2352 by 1568 pixels; CFP; FOV: 45 degrees:
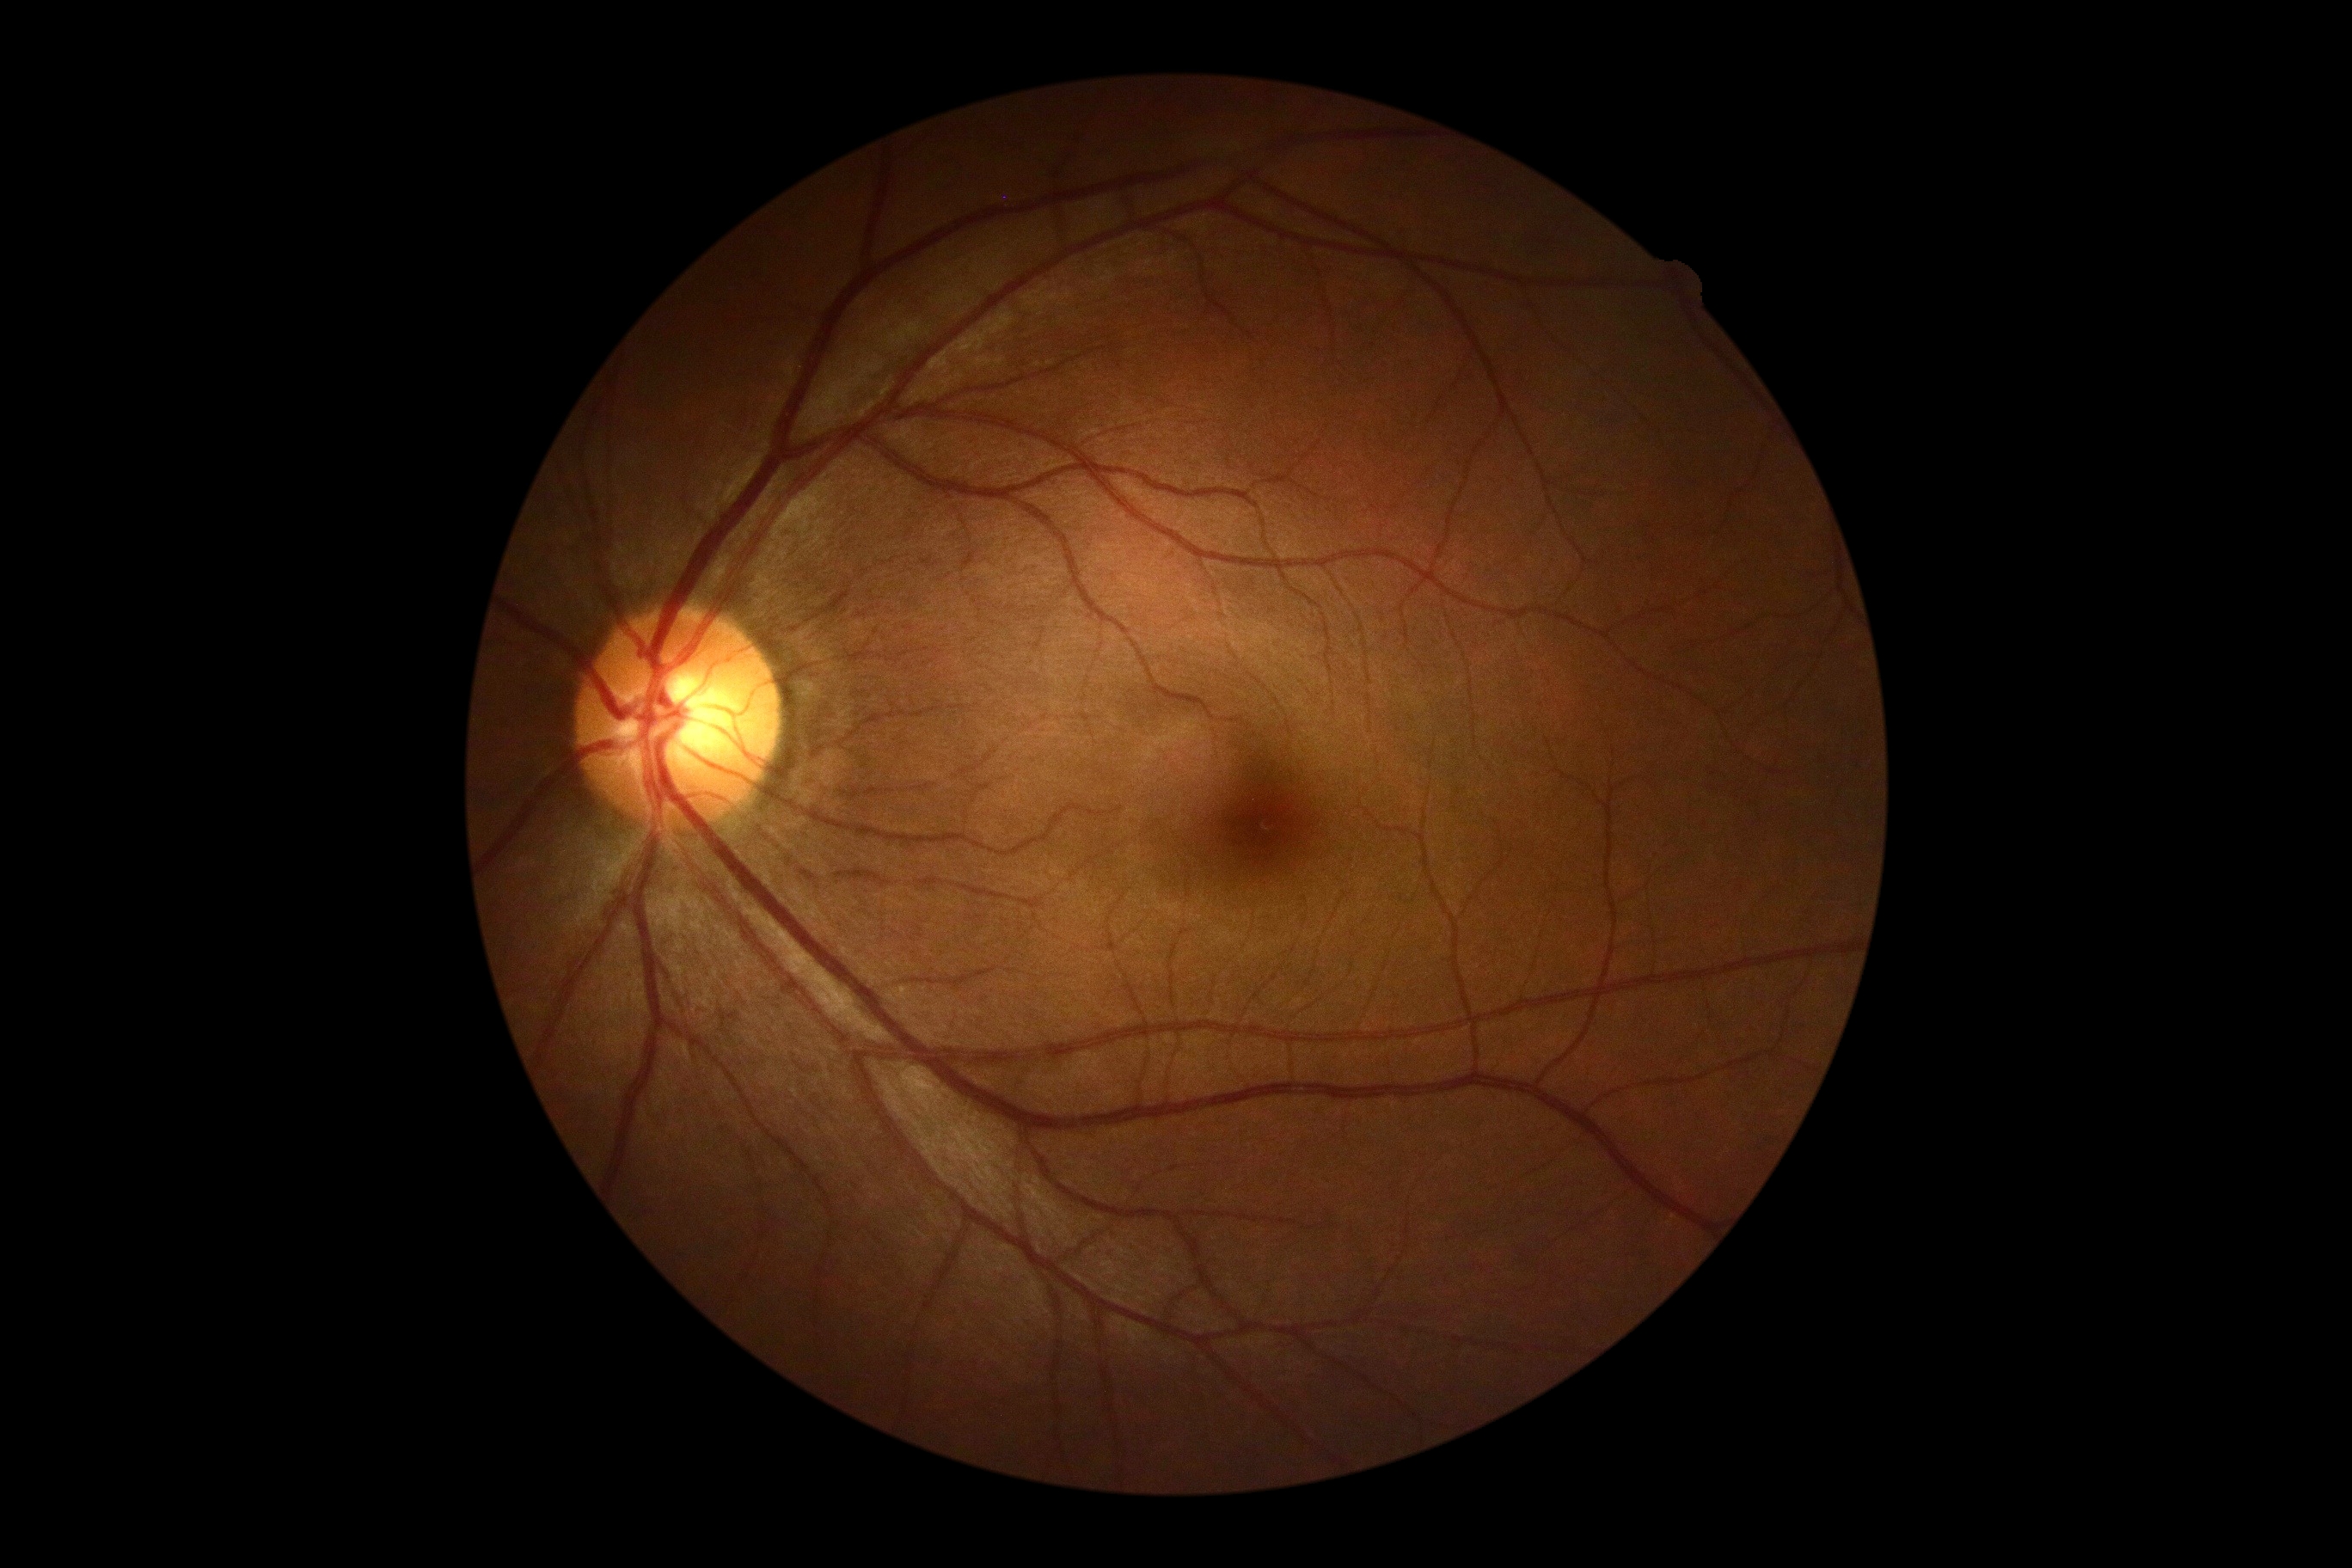

DR stage is no apparent retinopathy (grade 0). No apparent diabetic retinopathy.